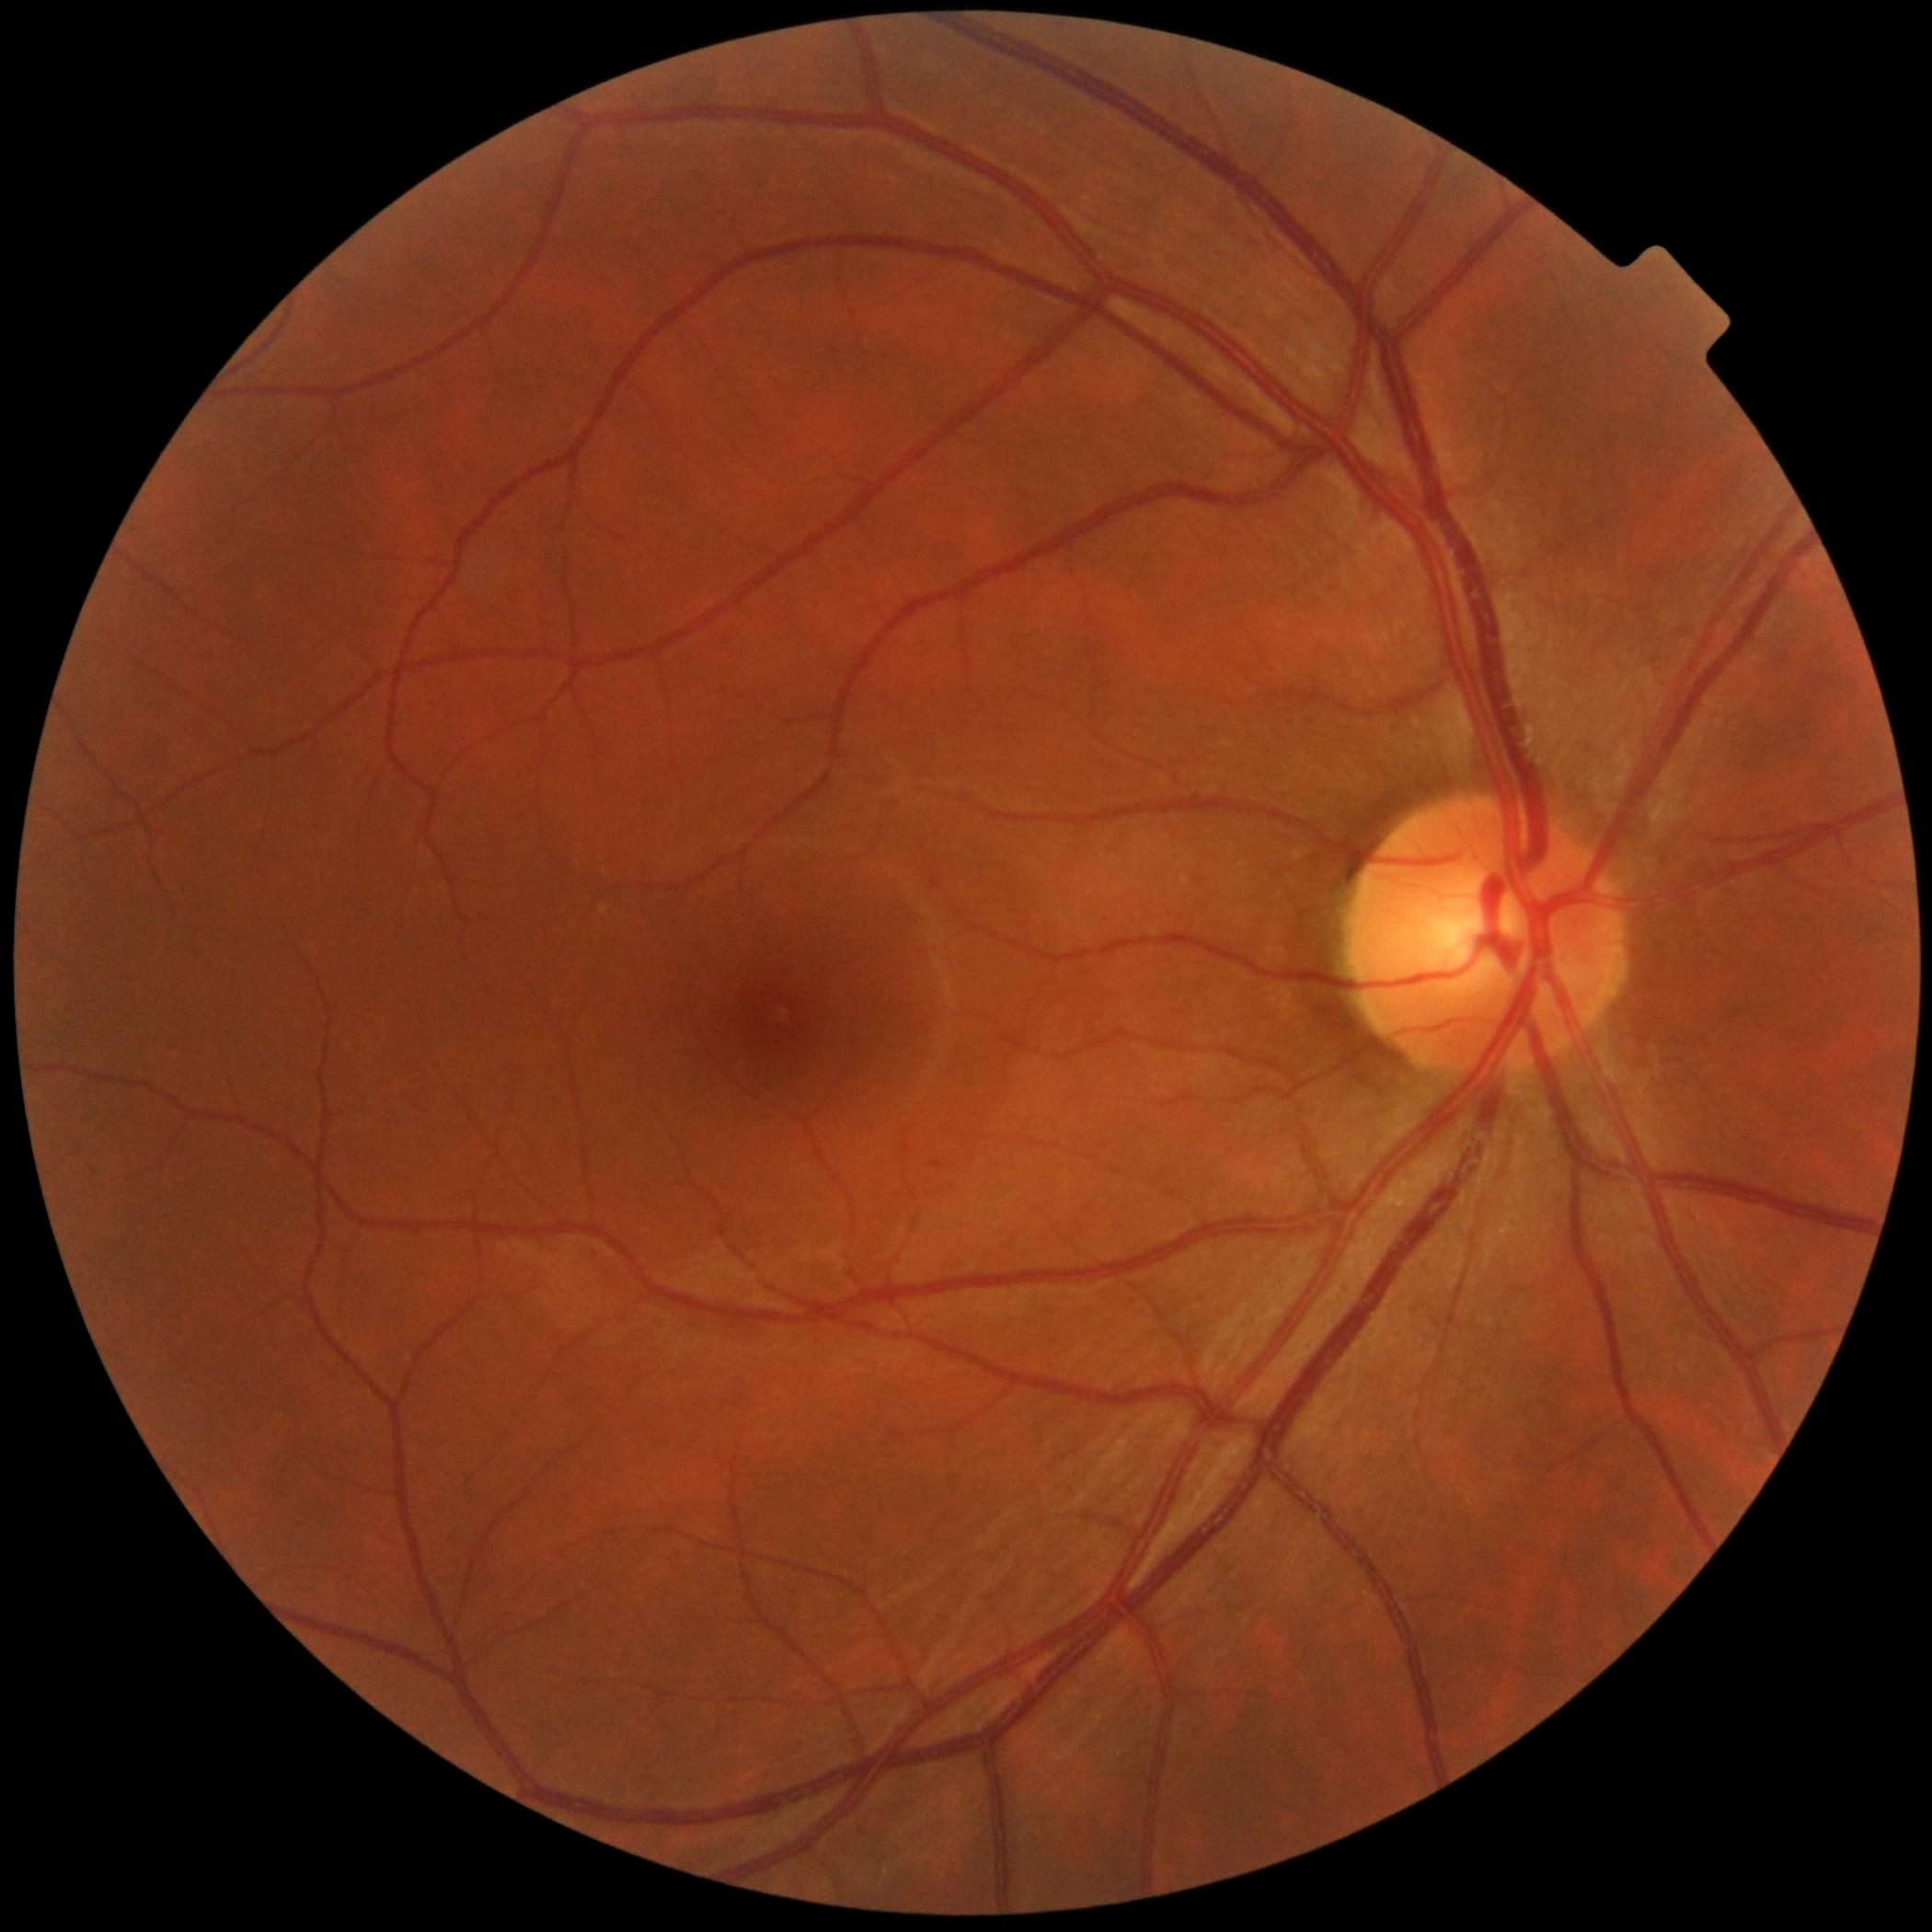 Annotations:
• diabetic retinopathy grade: no apparent diabetic retinopathy (0)